FOV: 45 degrees — 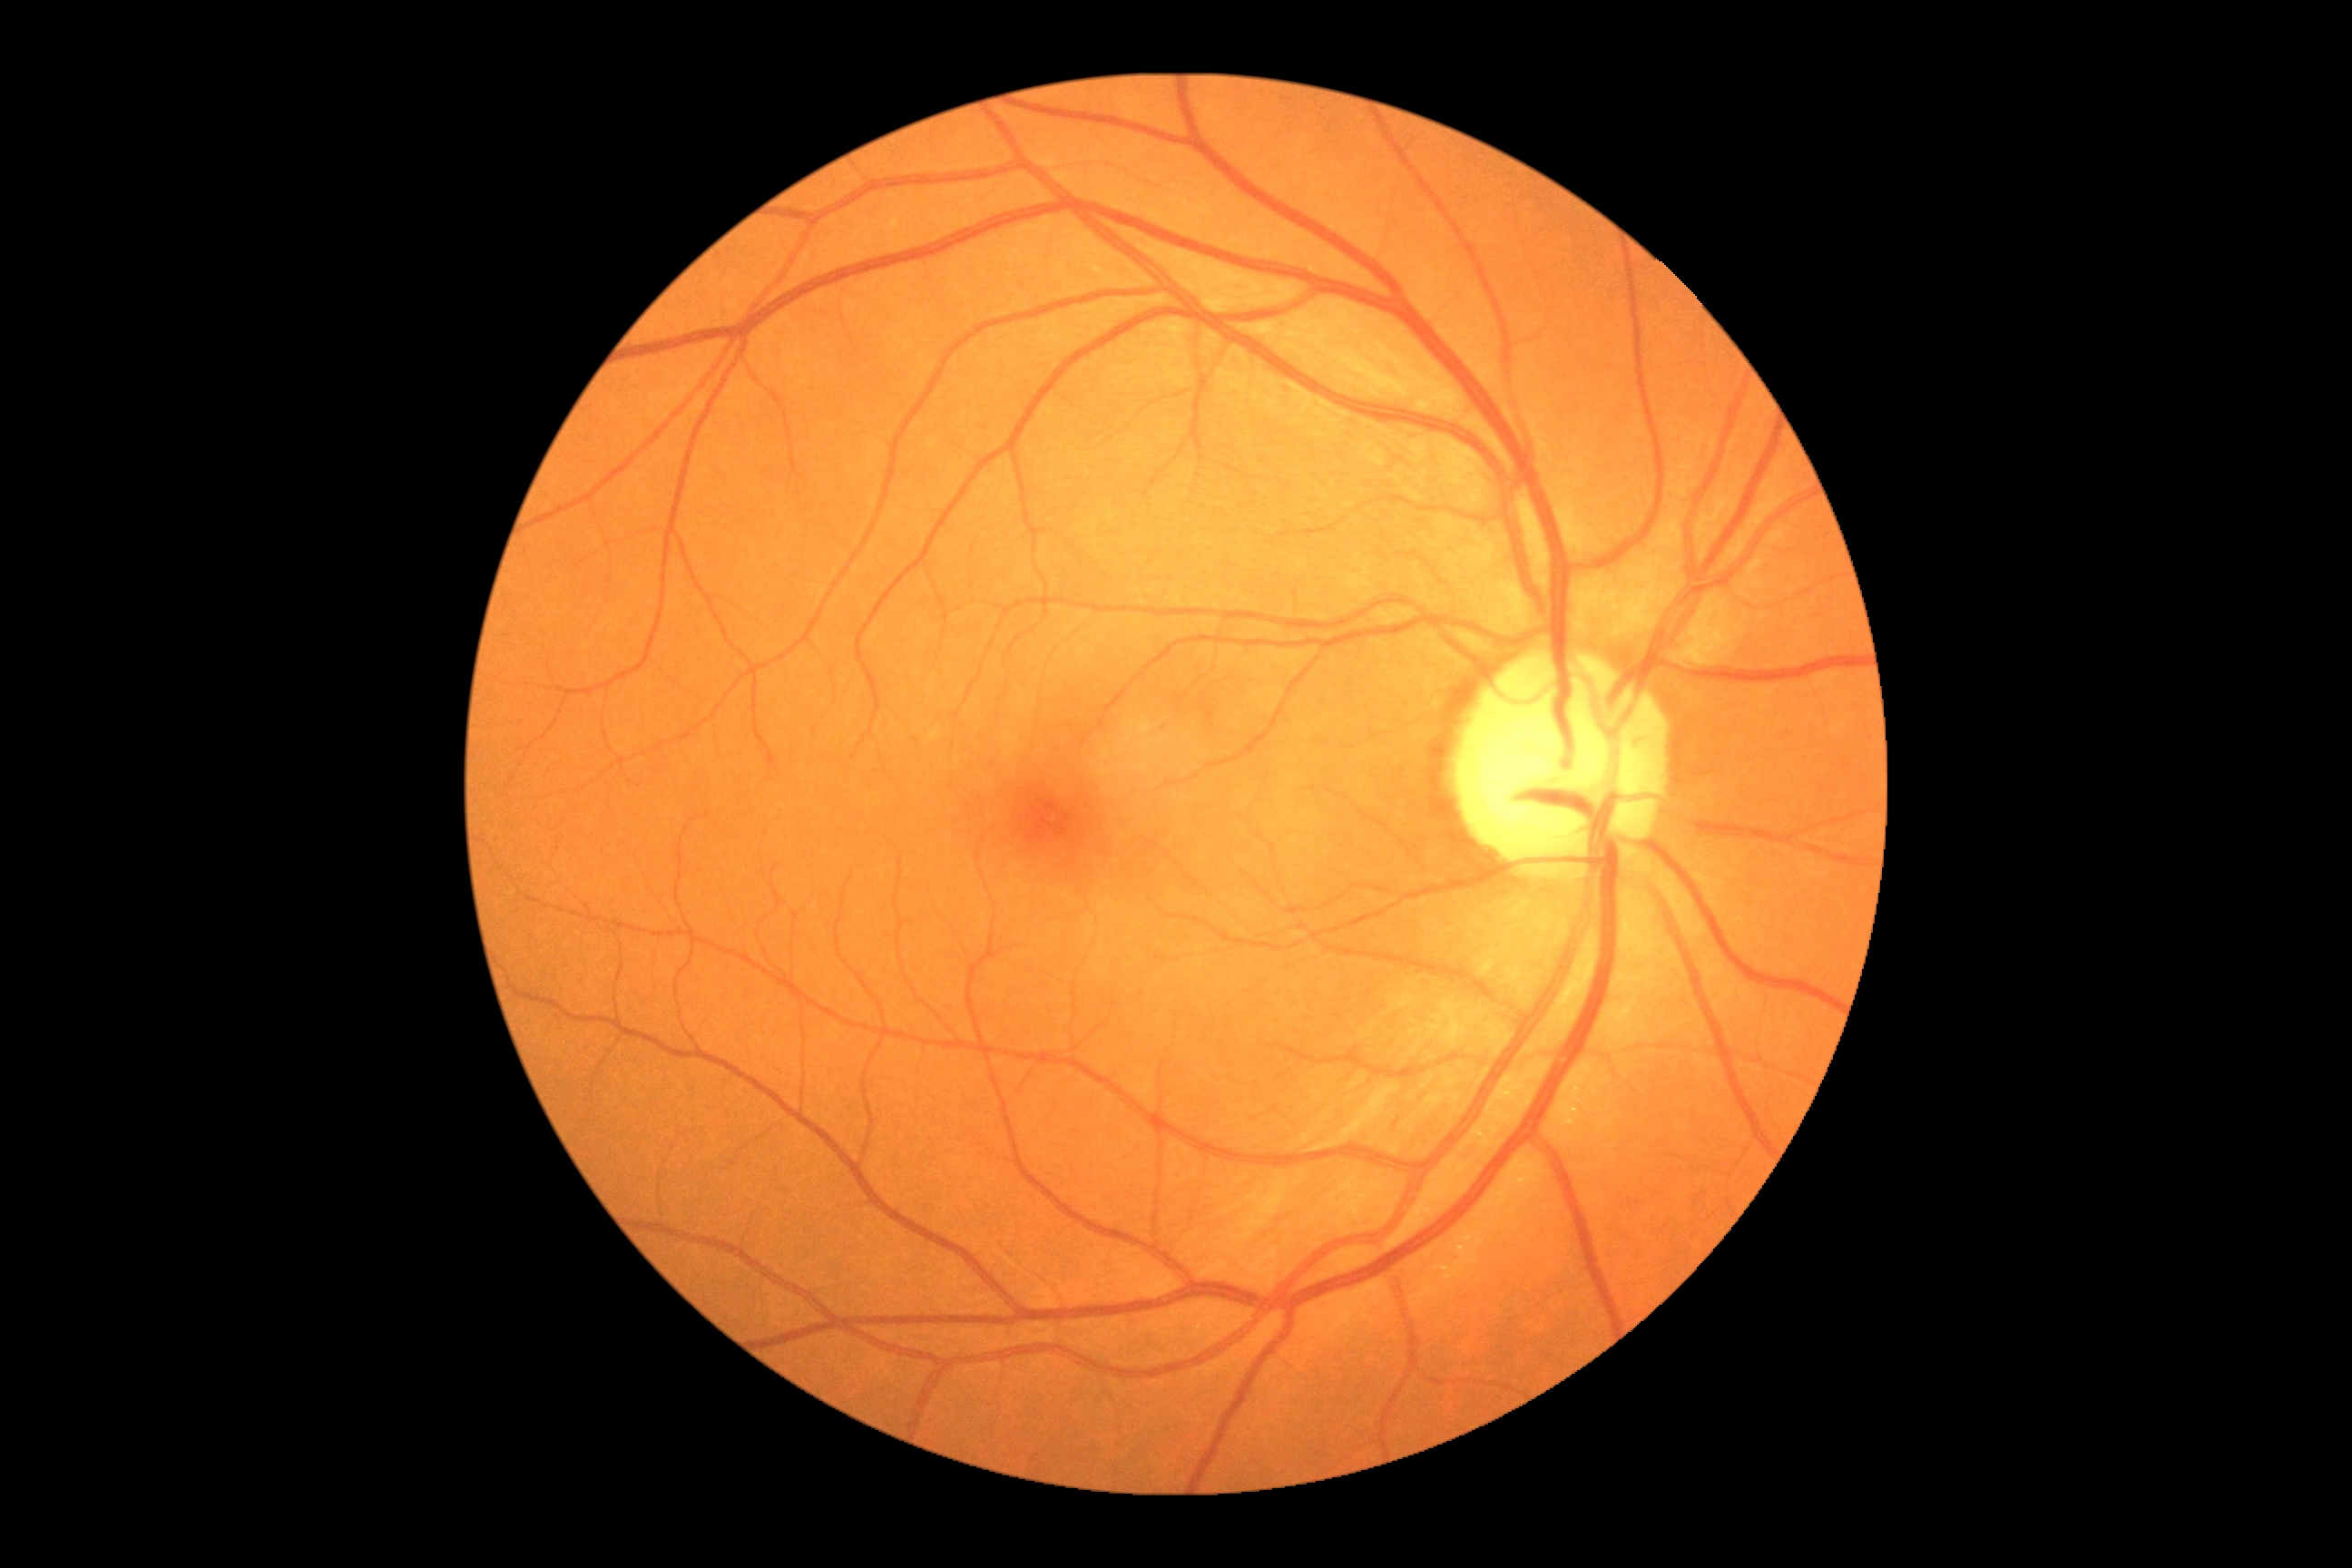

diabetic retinopathy (DR) = grade 0 (no apparent retinopathy), DR impression = no DR findings.